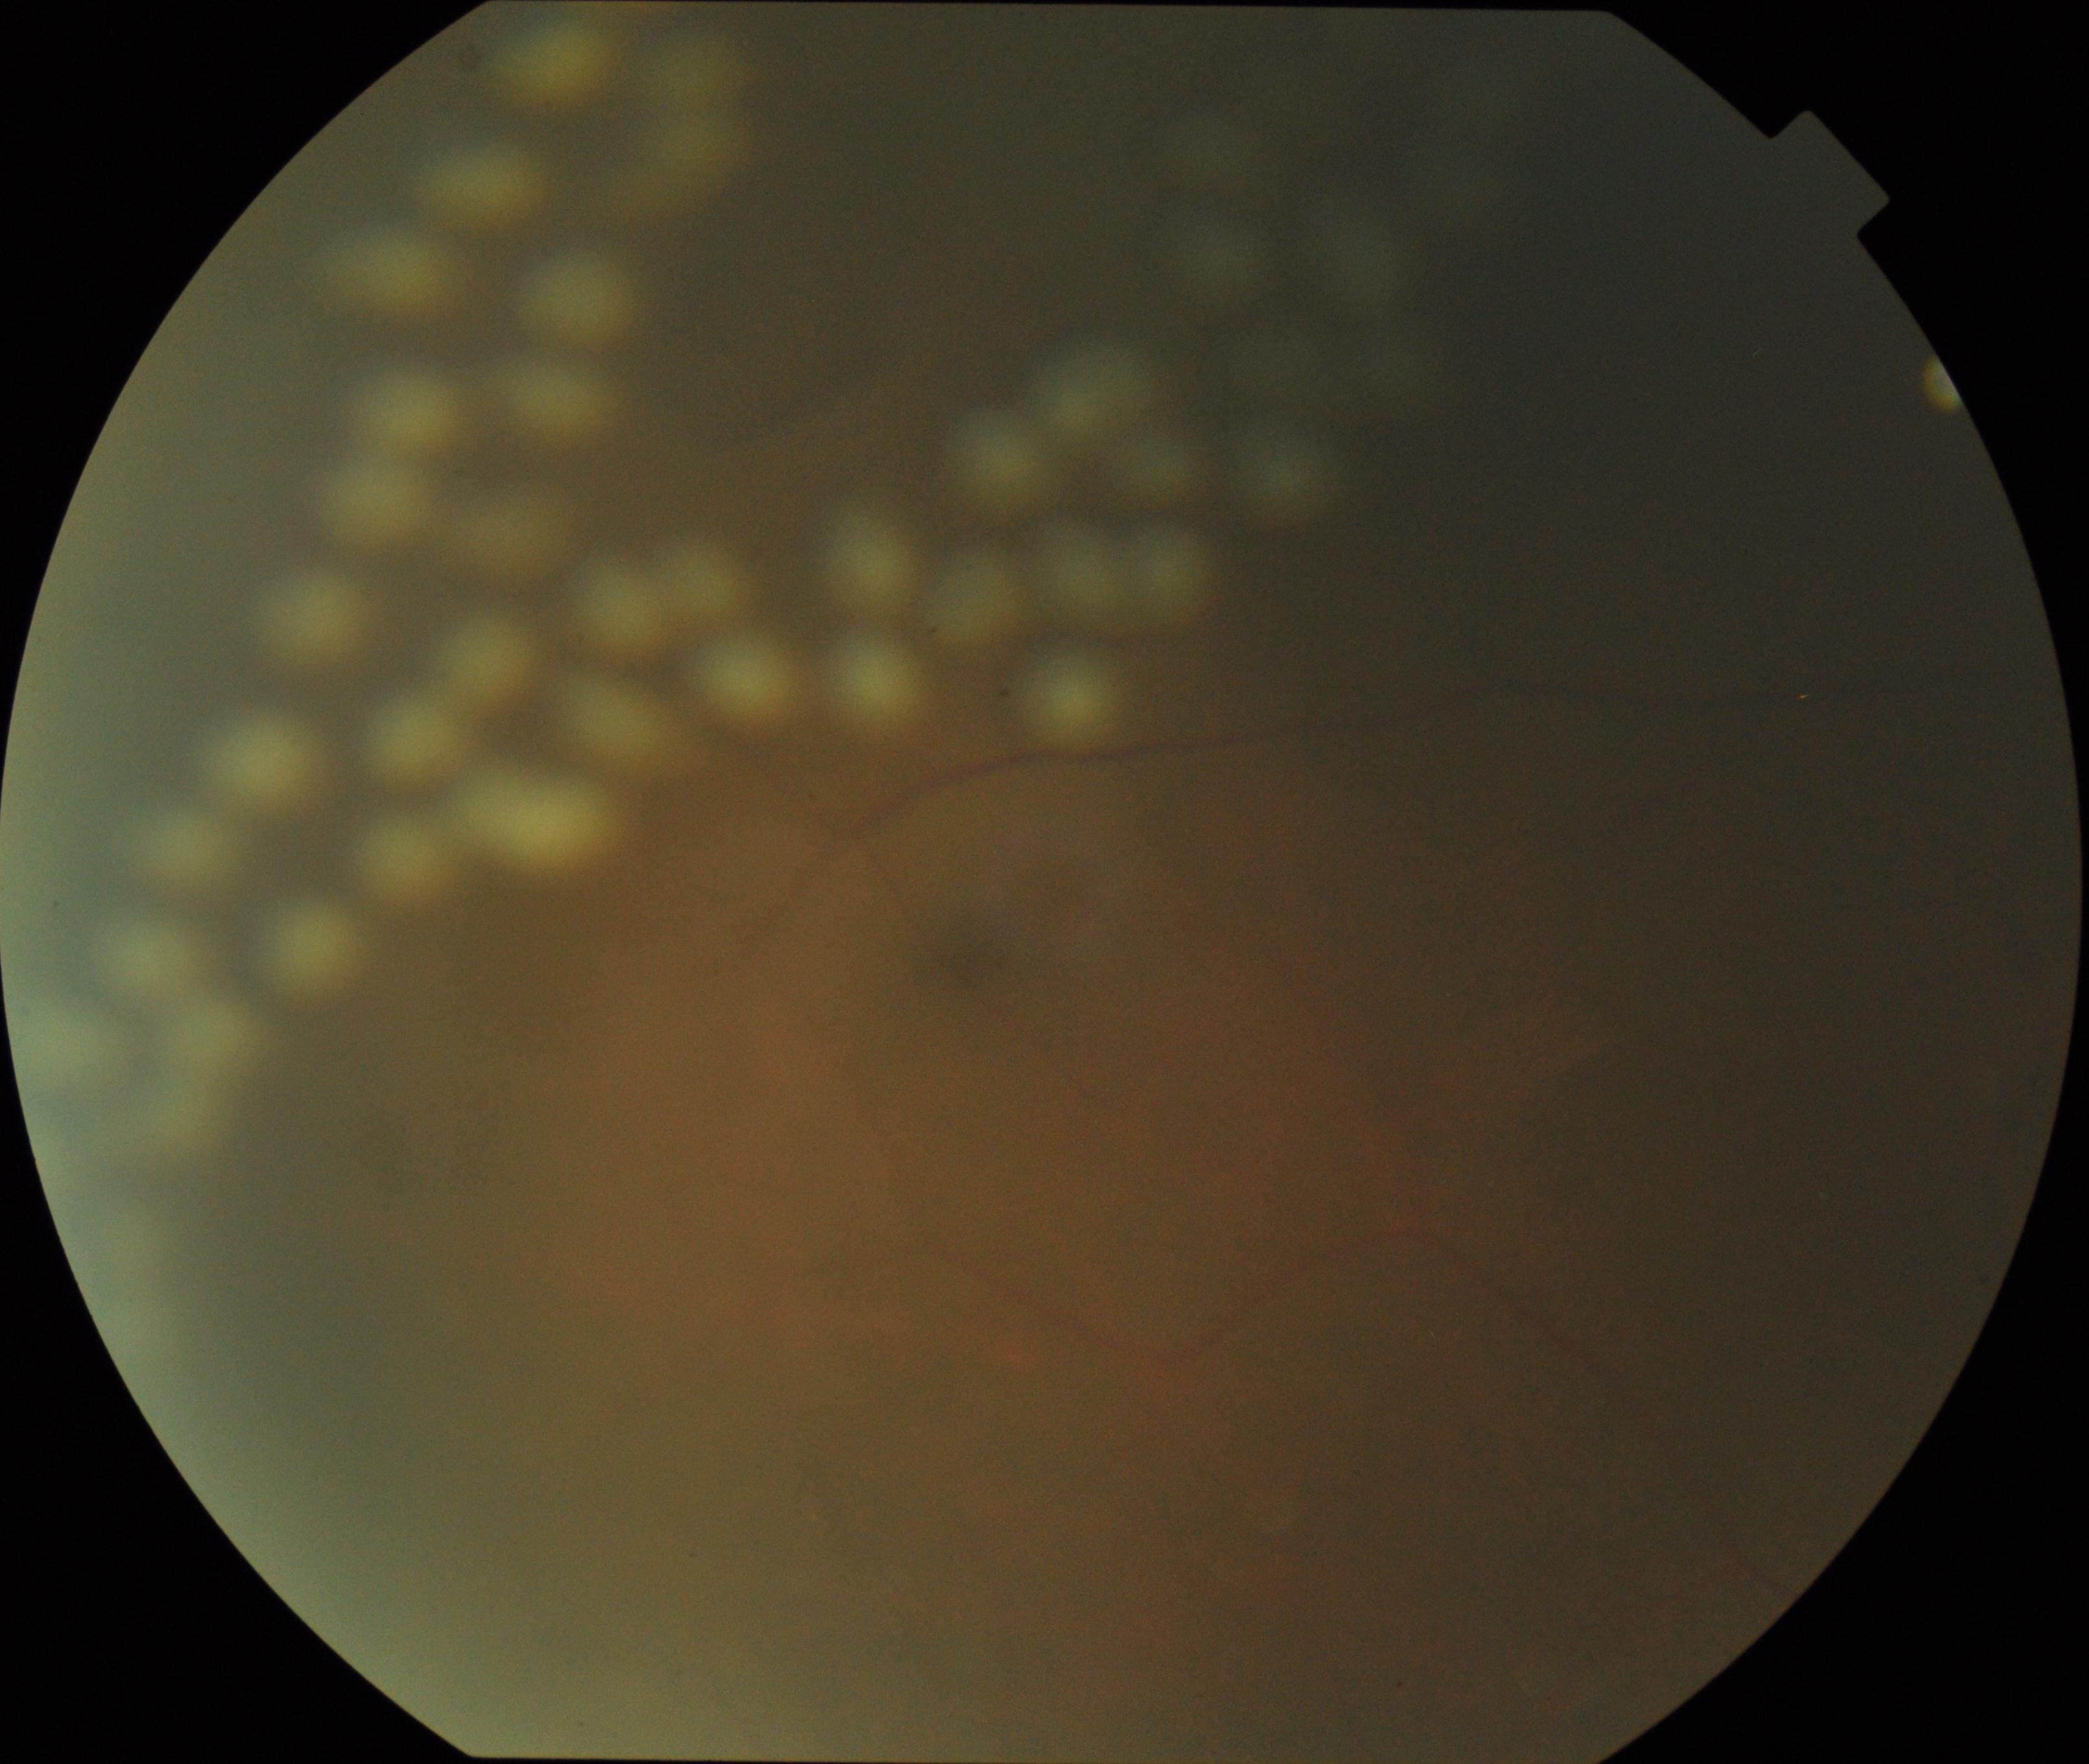

Impression: laser spots. Features include multiple, uniform, round, discrete yellow-white or brown lesions from photocoagulation.